Retinal fundus photograph; 2352x1568; FOV: 45 degrees
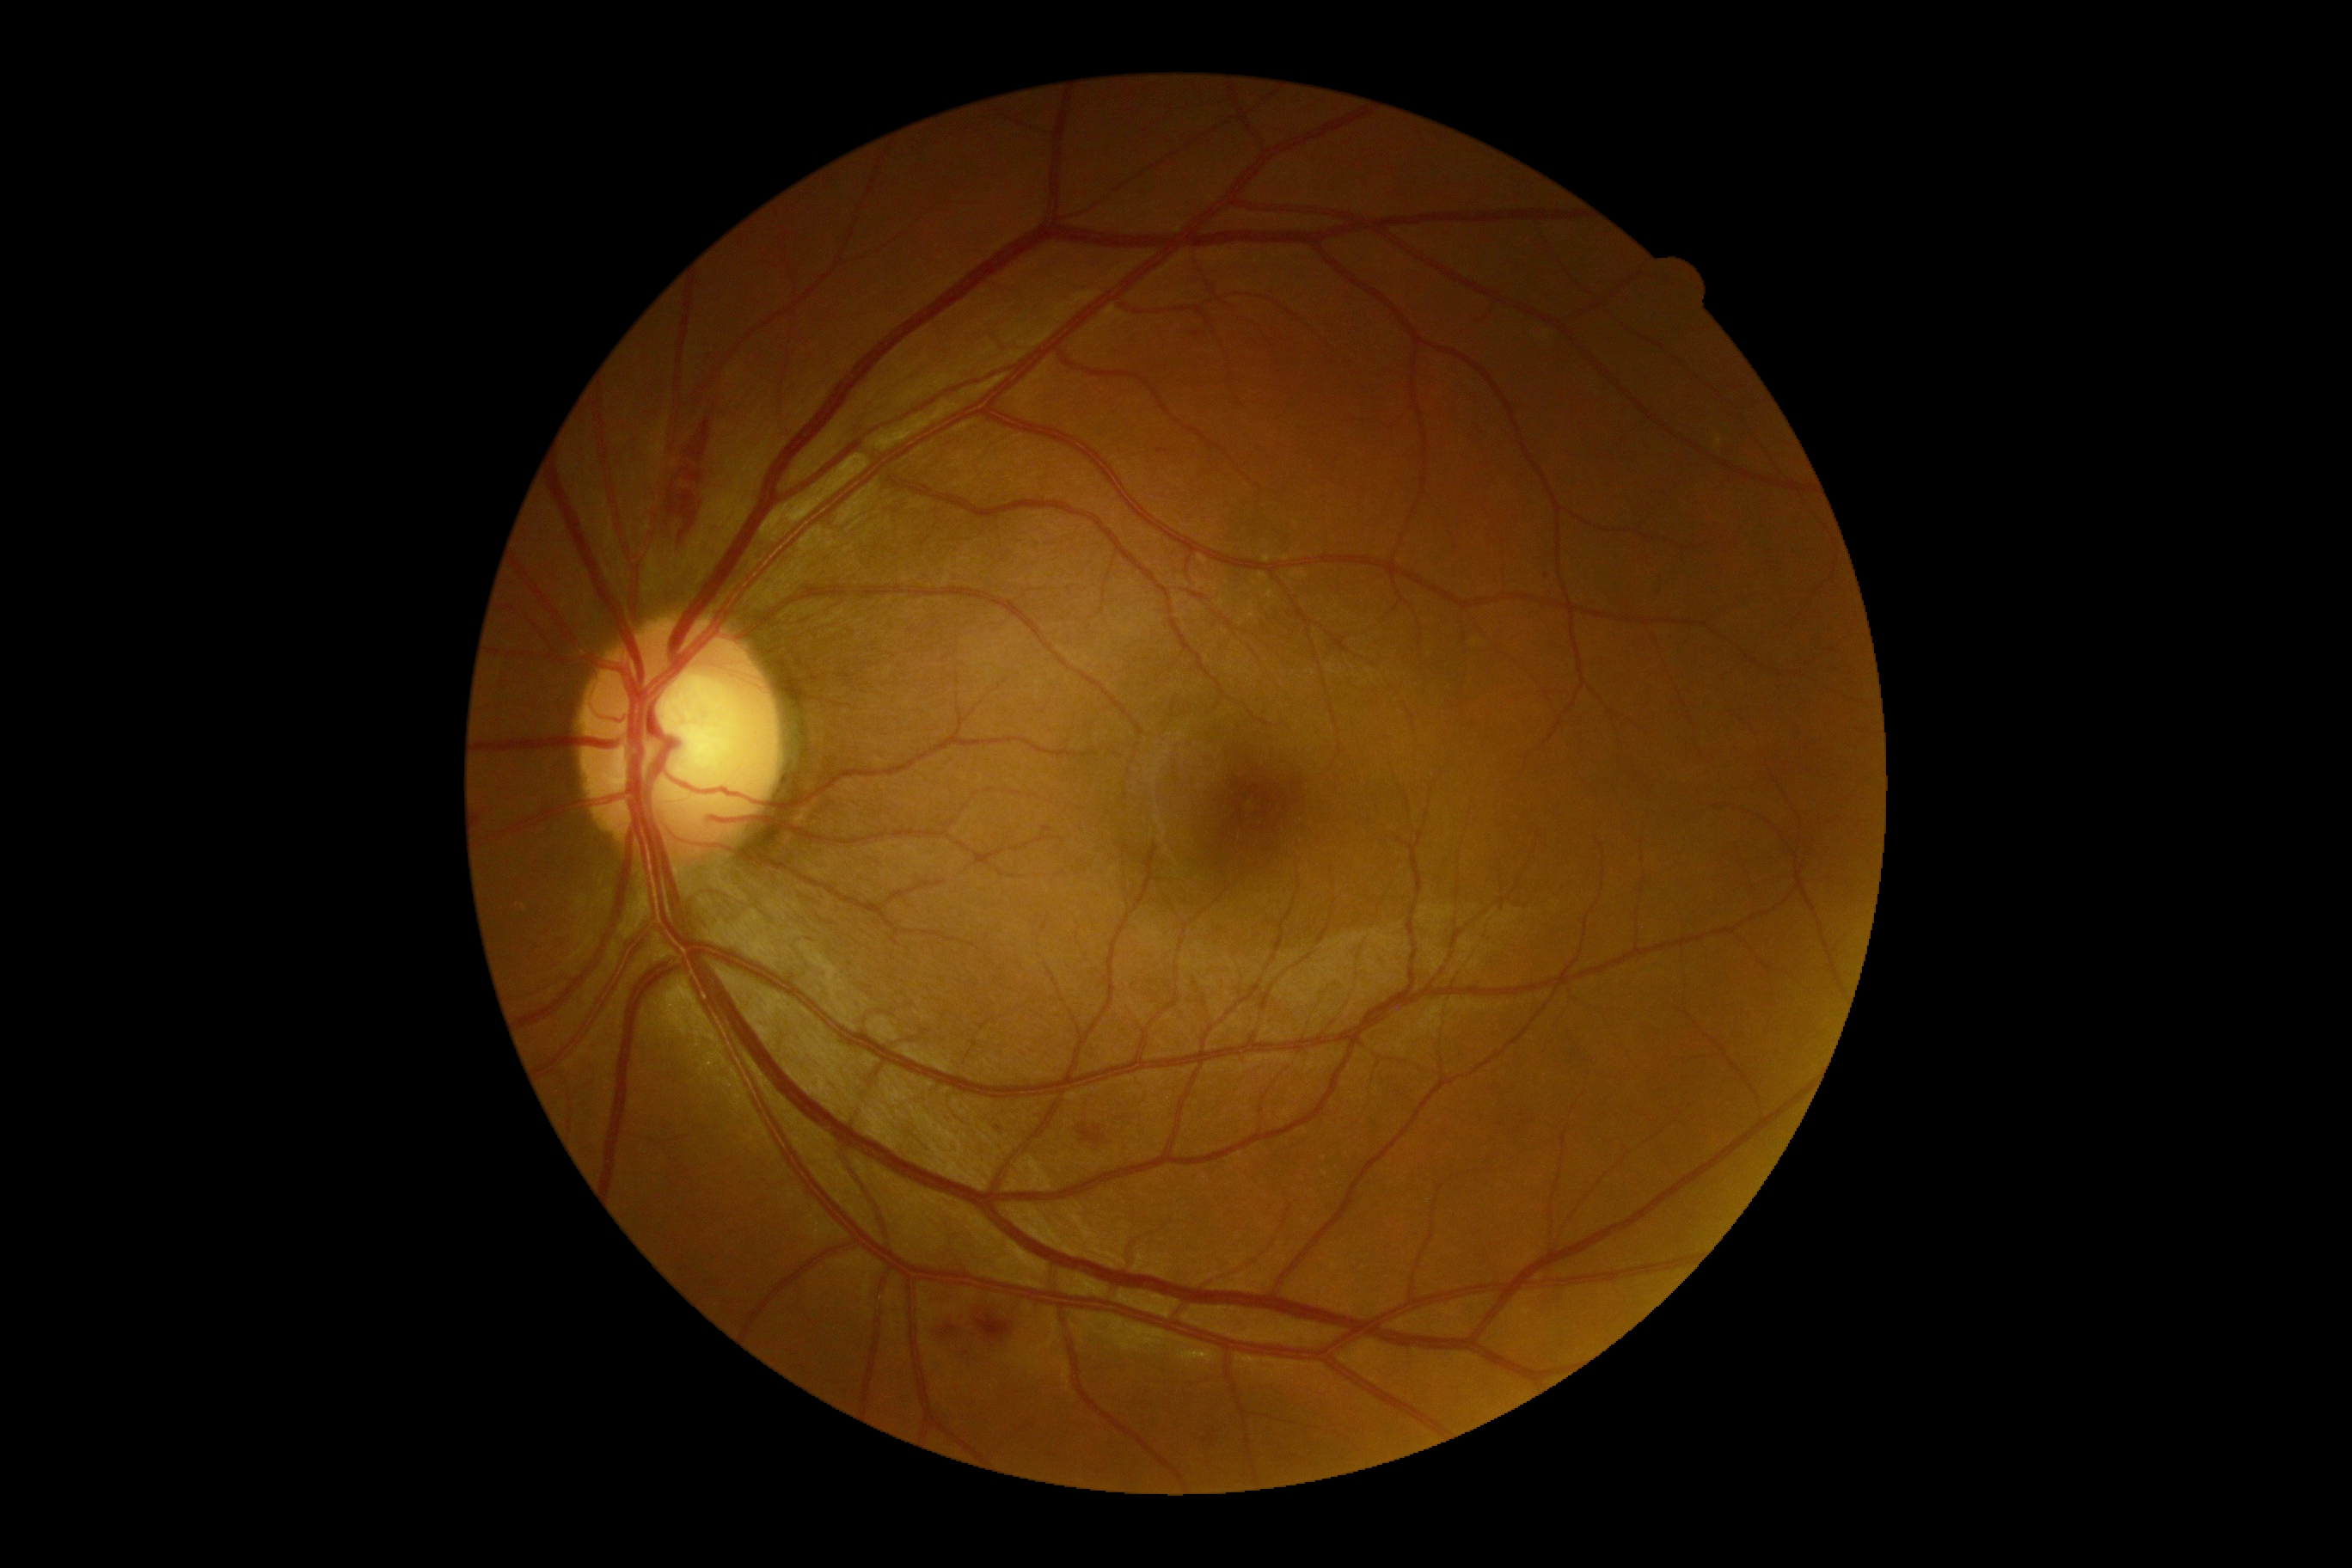 Retinopathy grade is 2.